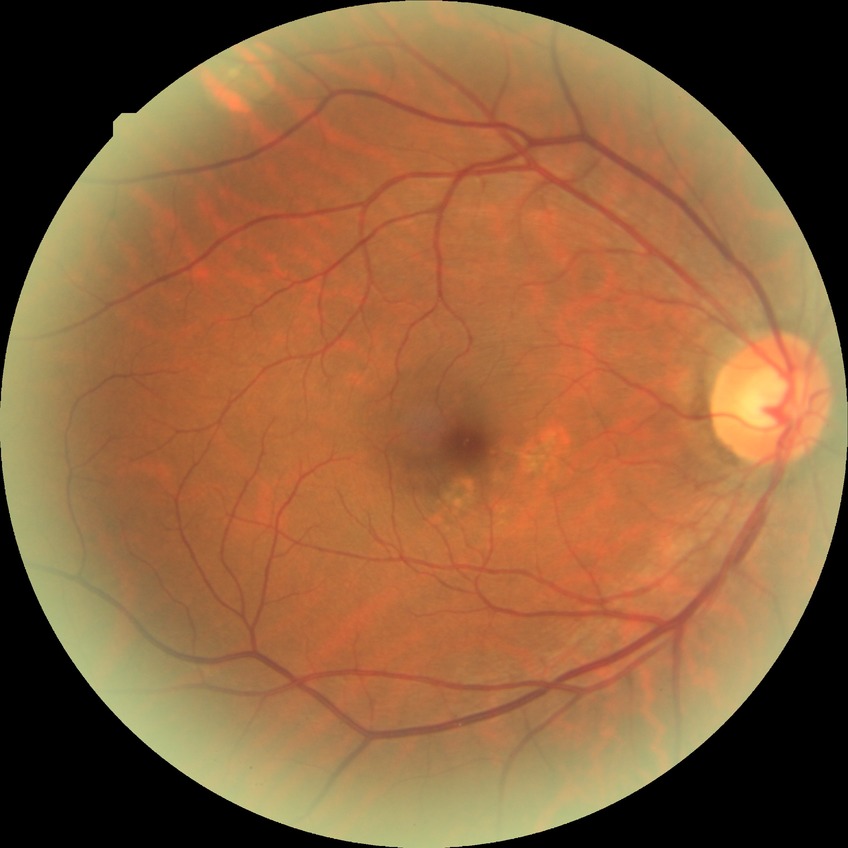 proliferative_class: non-proliferative diabetic retinopathy
davis_grade: simple diabetic retinopathy (SDR)